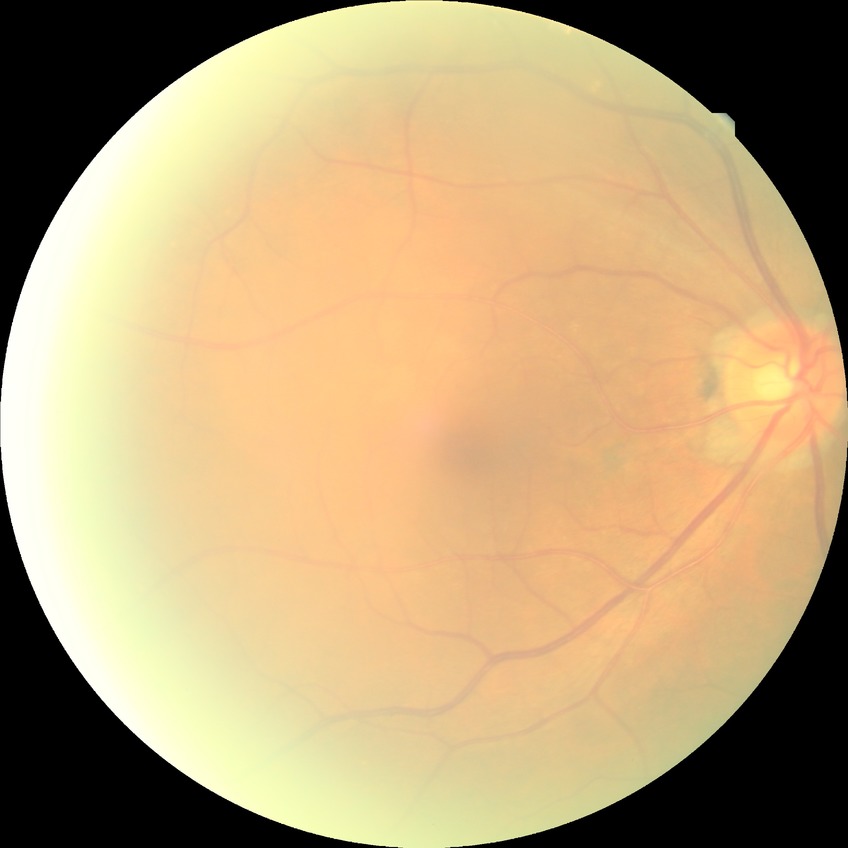 Annotations:
* diabetic retinopathy (DR): no diabetic retinopathy (NDR)